Fundus photo:
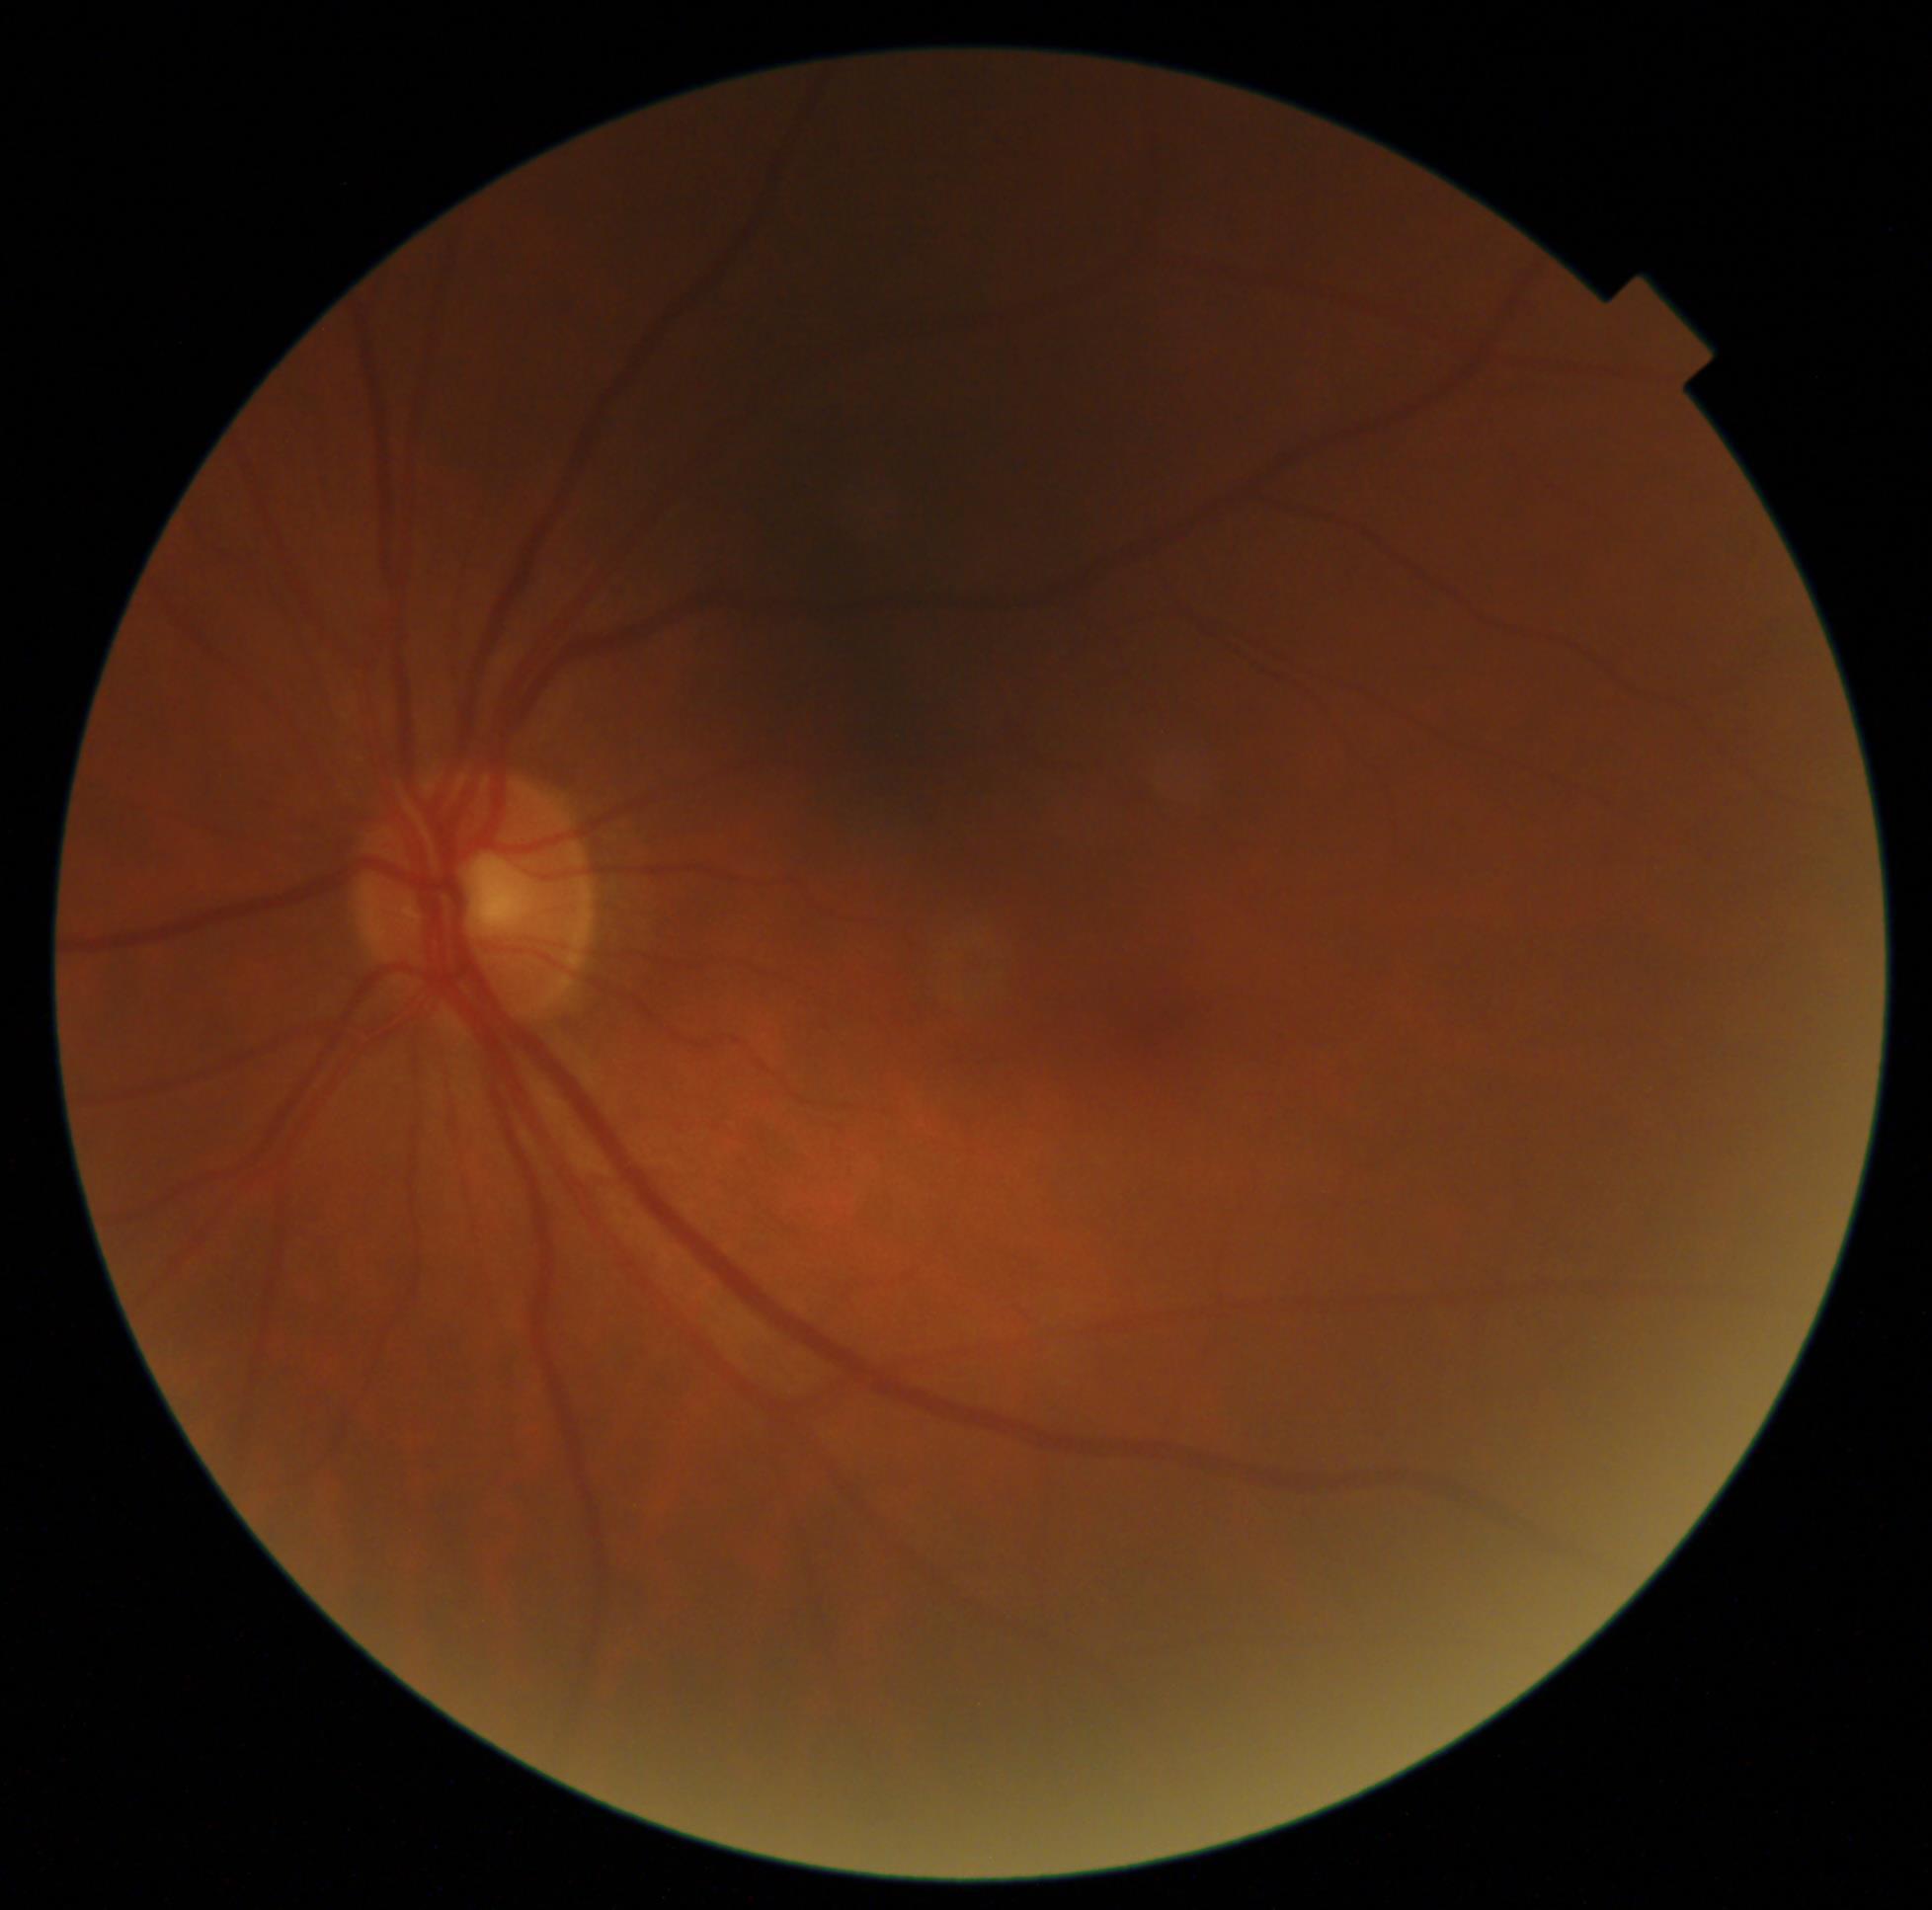

diabetic retinopathy (DR) = grade 0.